2352x1568px: 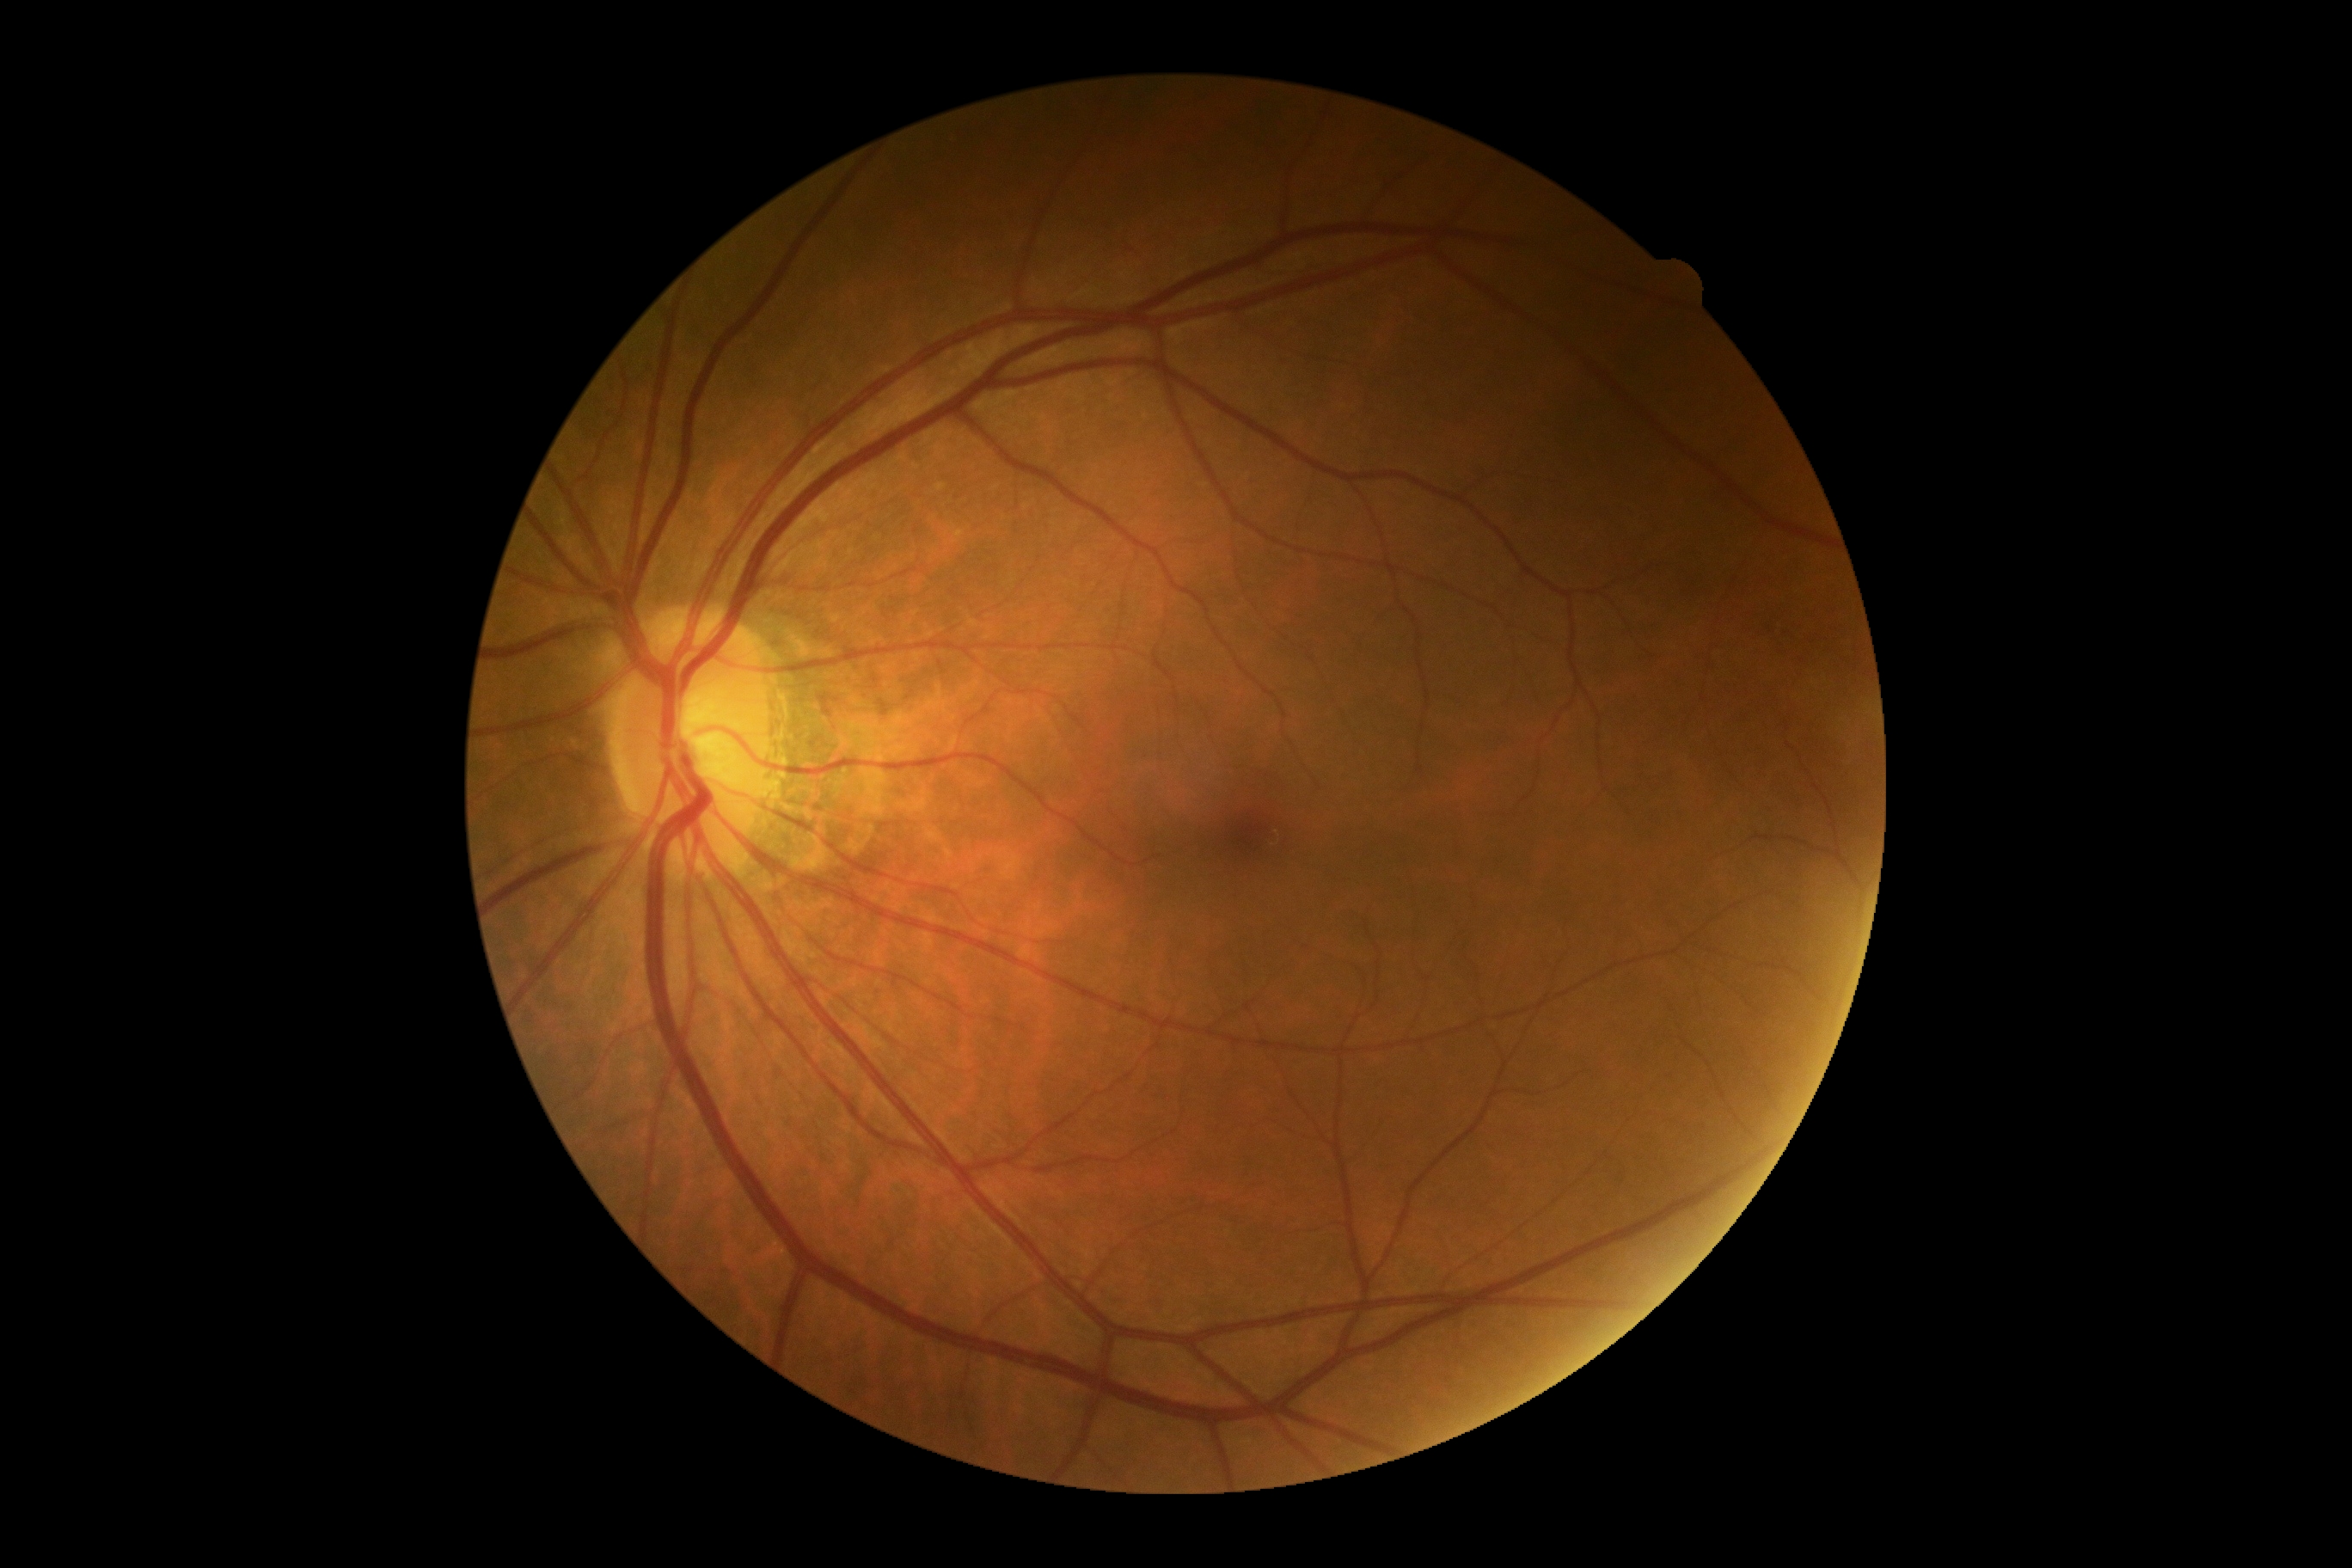

No diabetic retinal disease findings. DR grade is no apparent retinopathy (0).